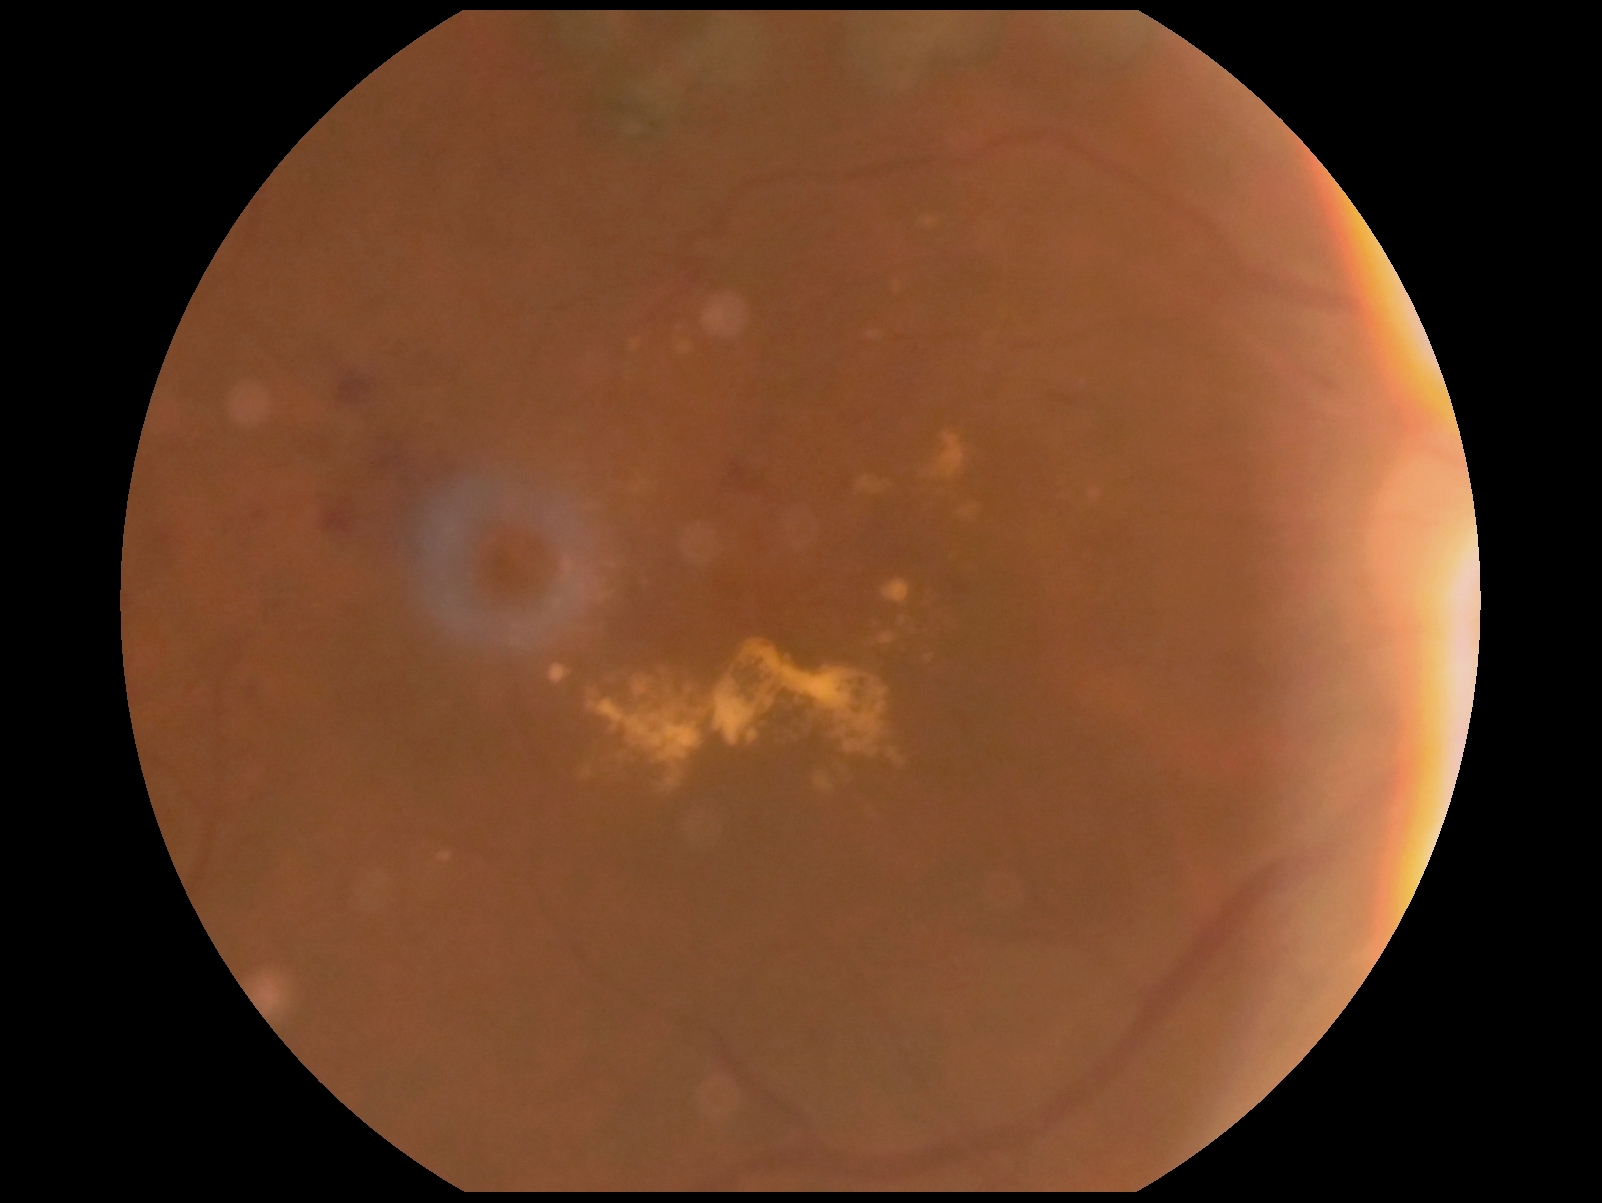

DR grade is 2 — more than just microaneurysms but less than severe NPDR.